CFP. 45° field of view
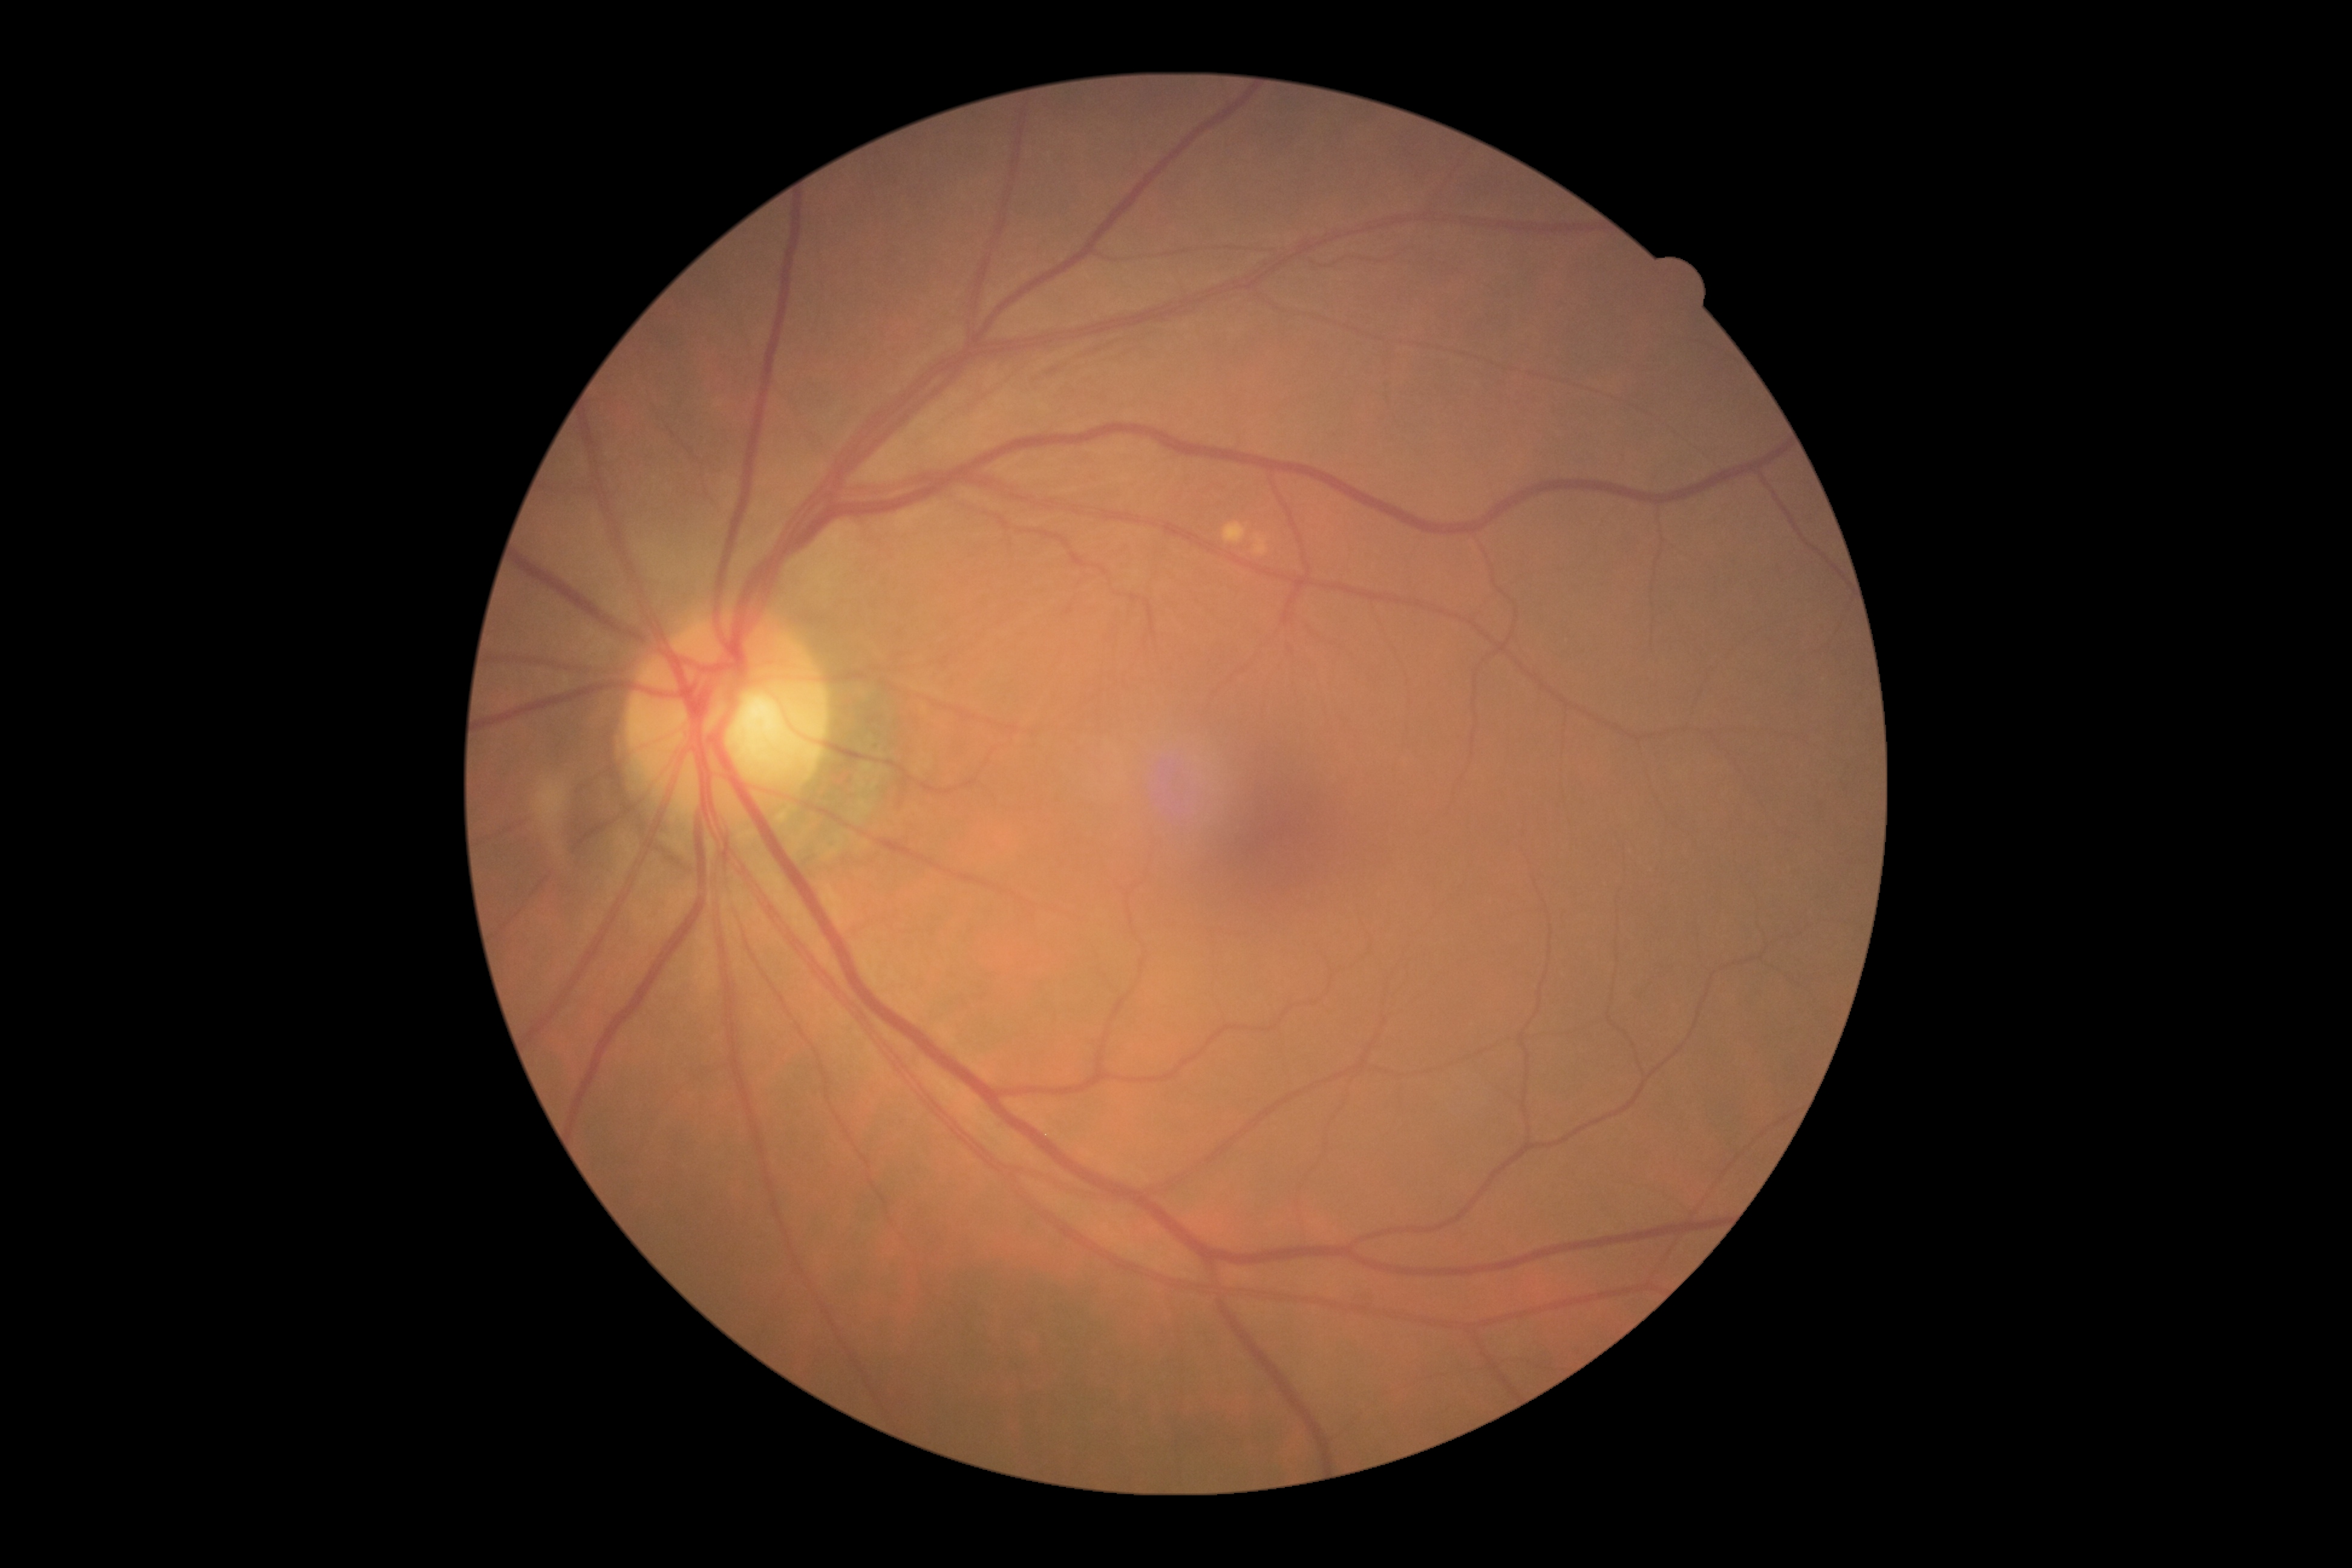
Diabetic retinopathy grade: no apparent diabetic retinopathy (0) — no visible signs of diabetic retinopathy.